2352x1568
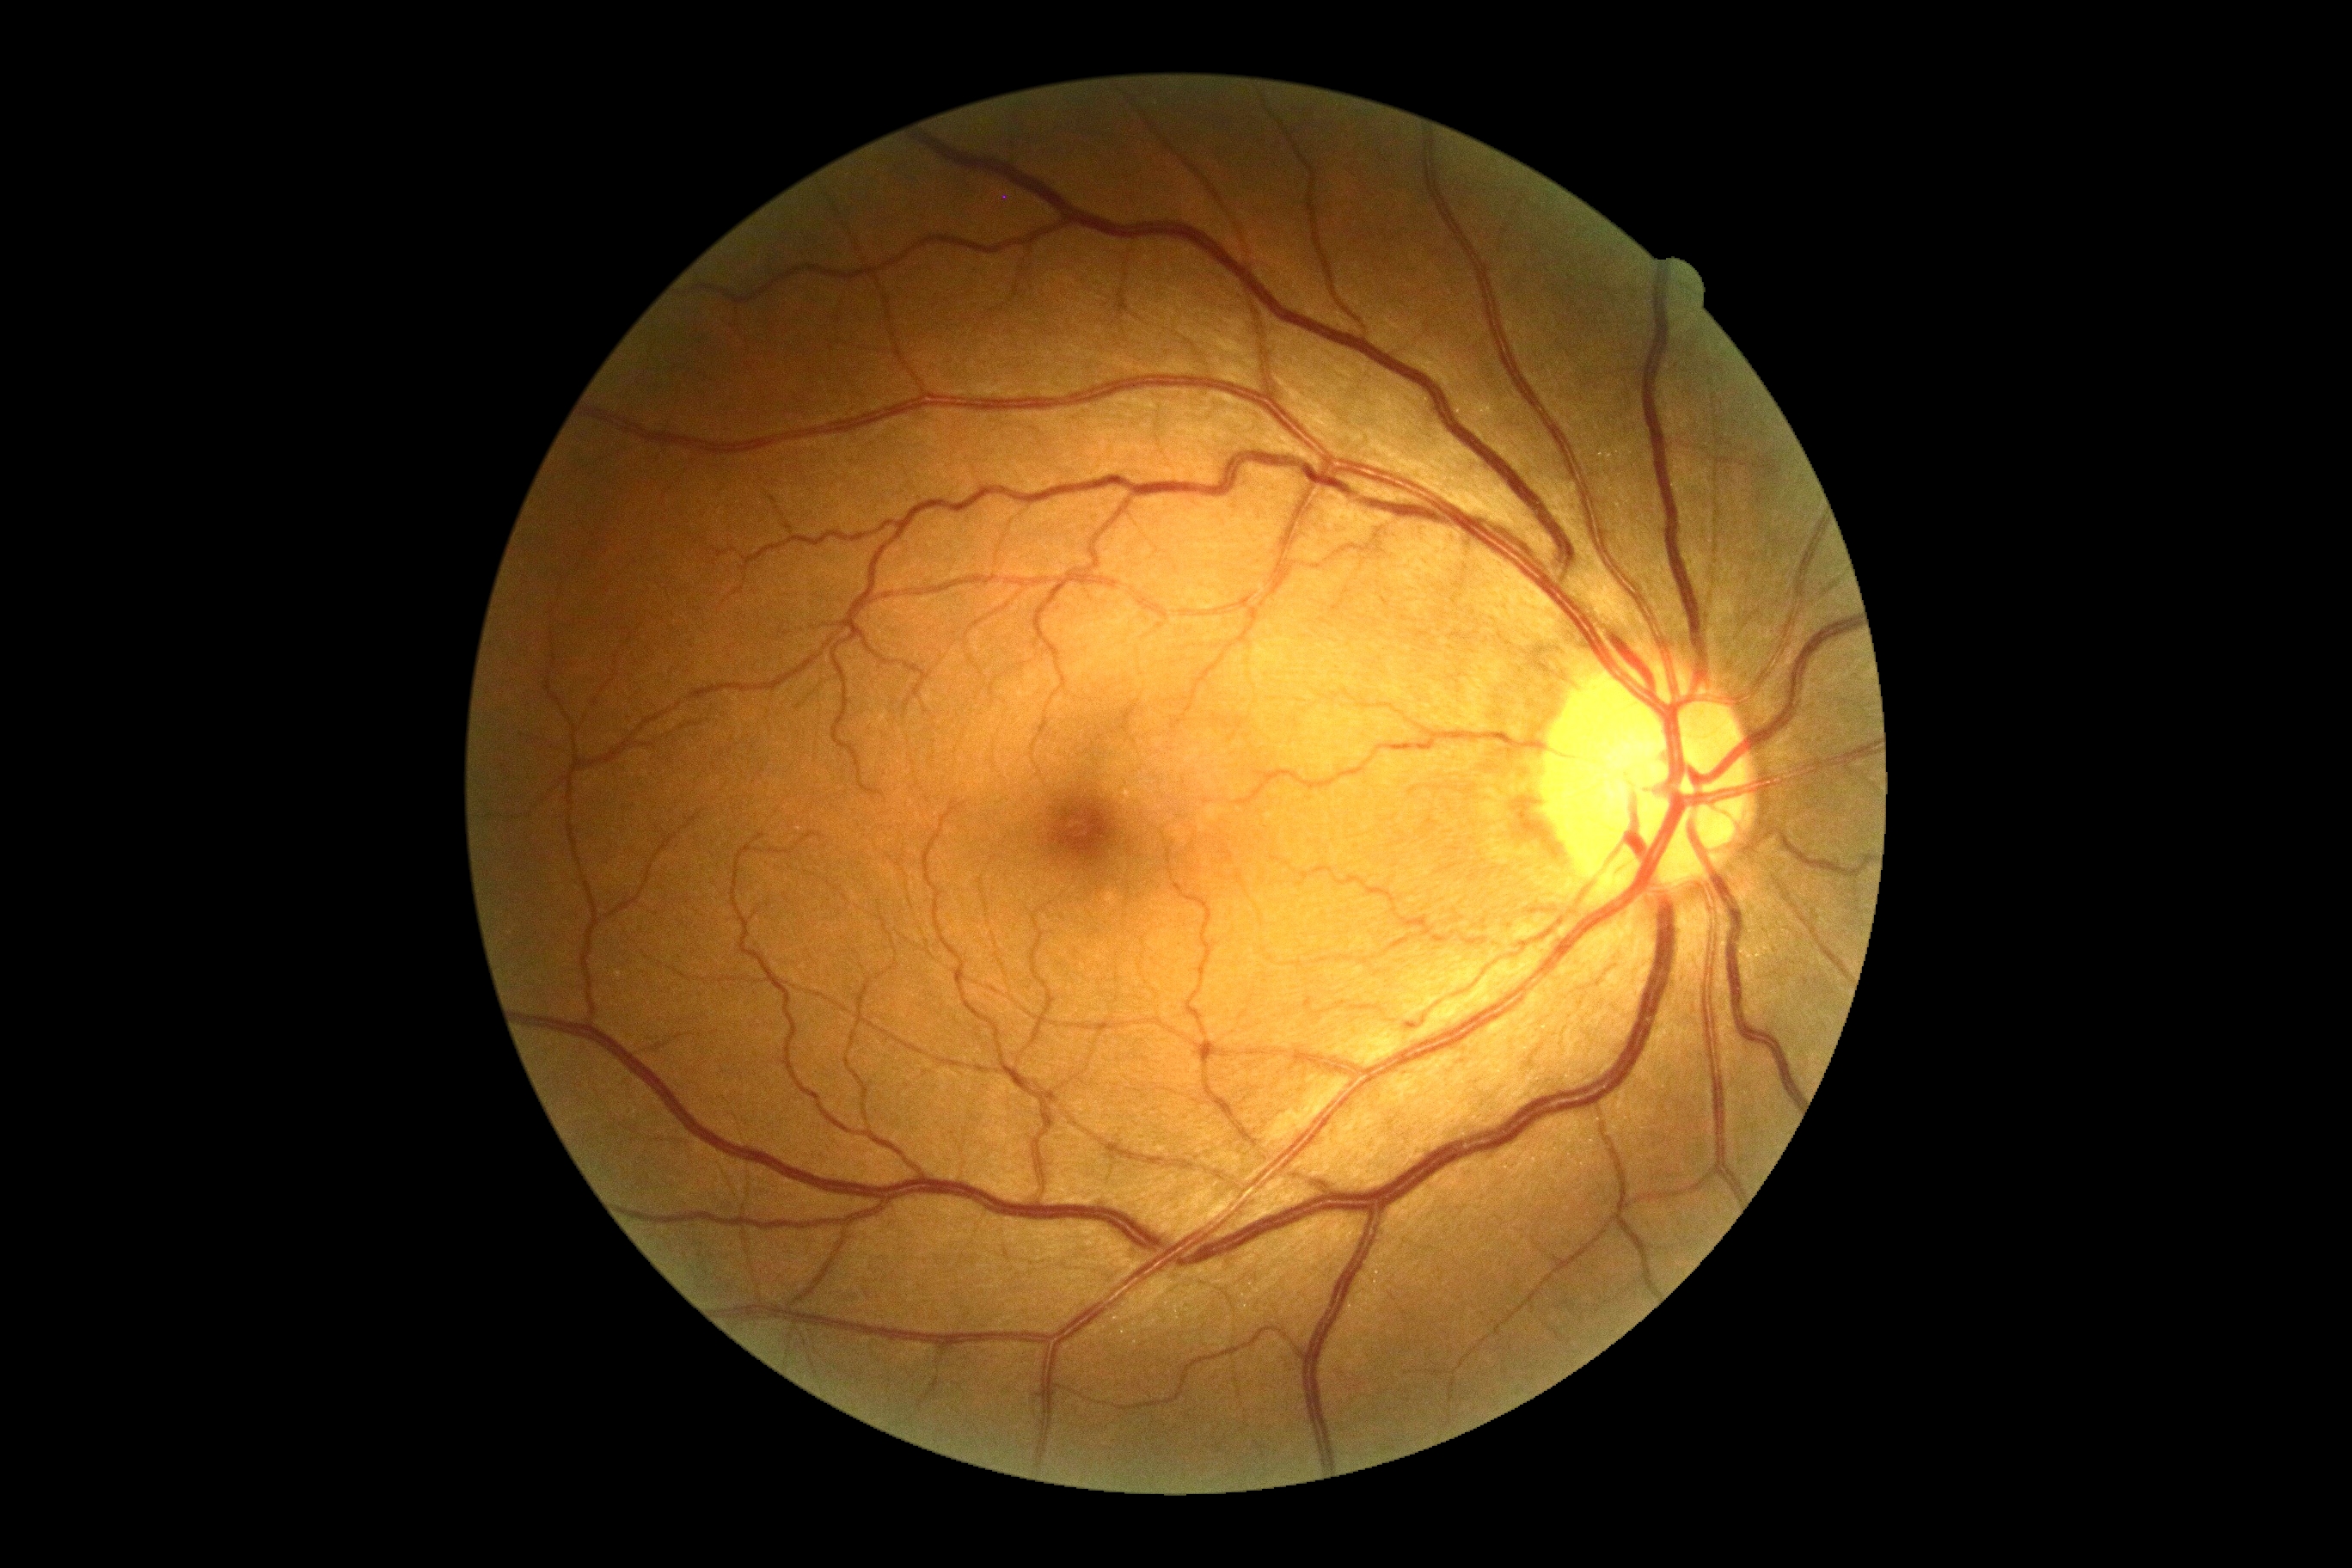 Findings:
- retinopathy: no apparent diabetic retinopathy (grade 0)